Image size 848x848. Posterior pole color fundus photograph. DR severity per modified Davis staging: 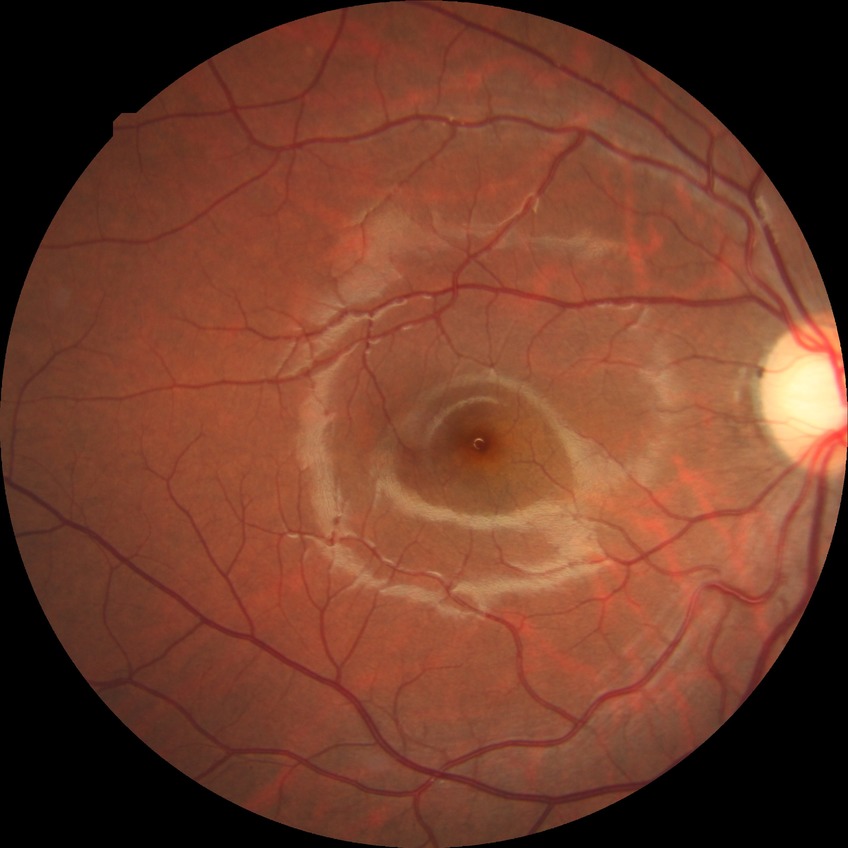

davis_grade: no diabetic retinopathy